CFP: 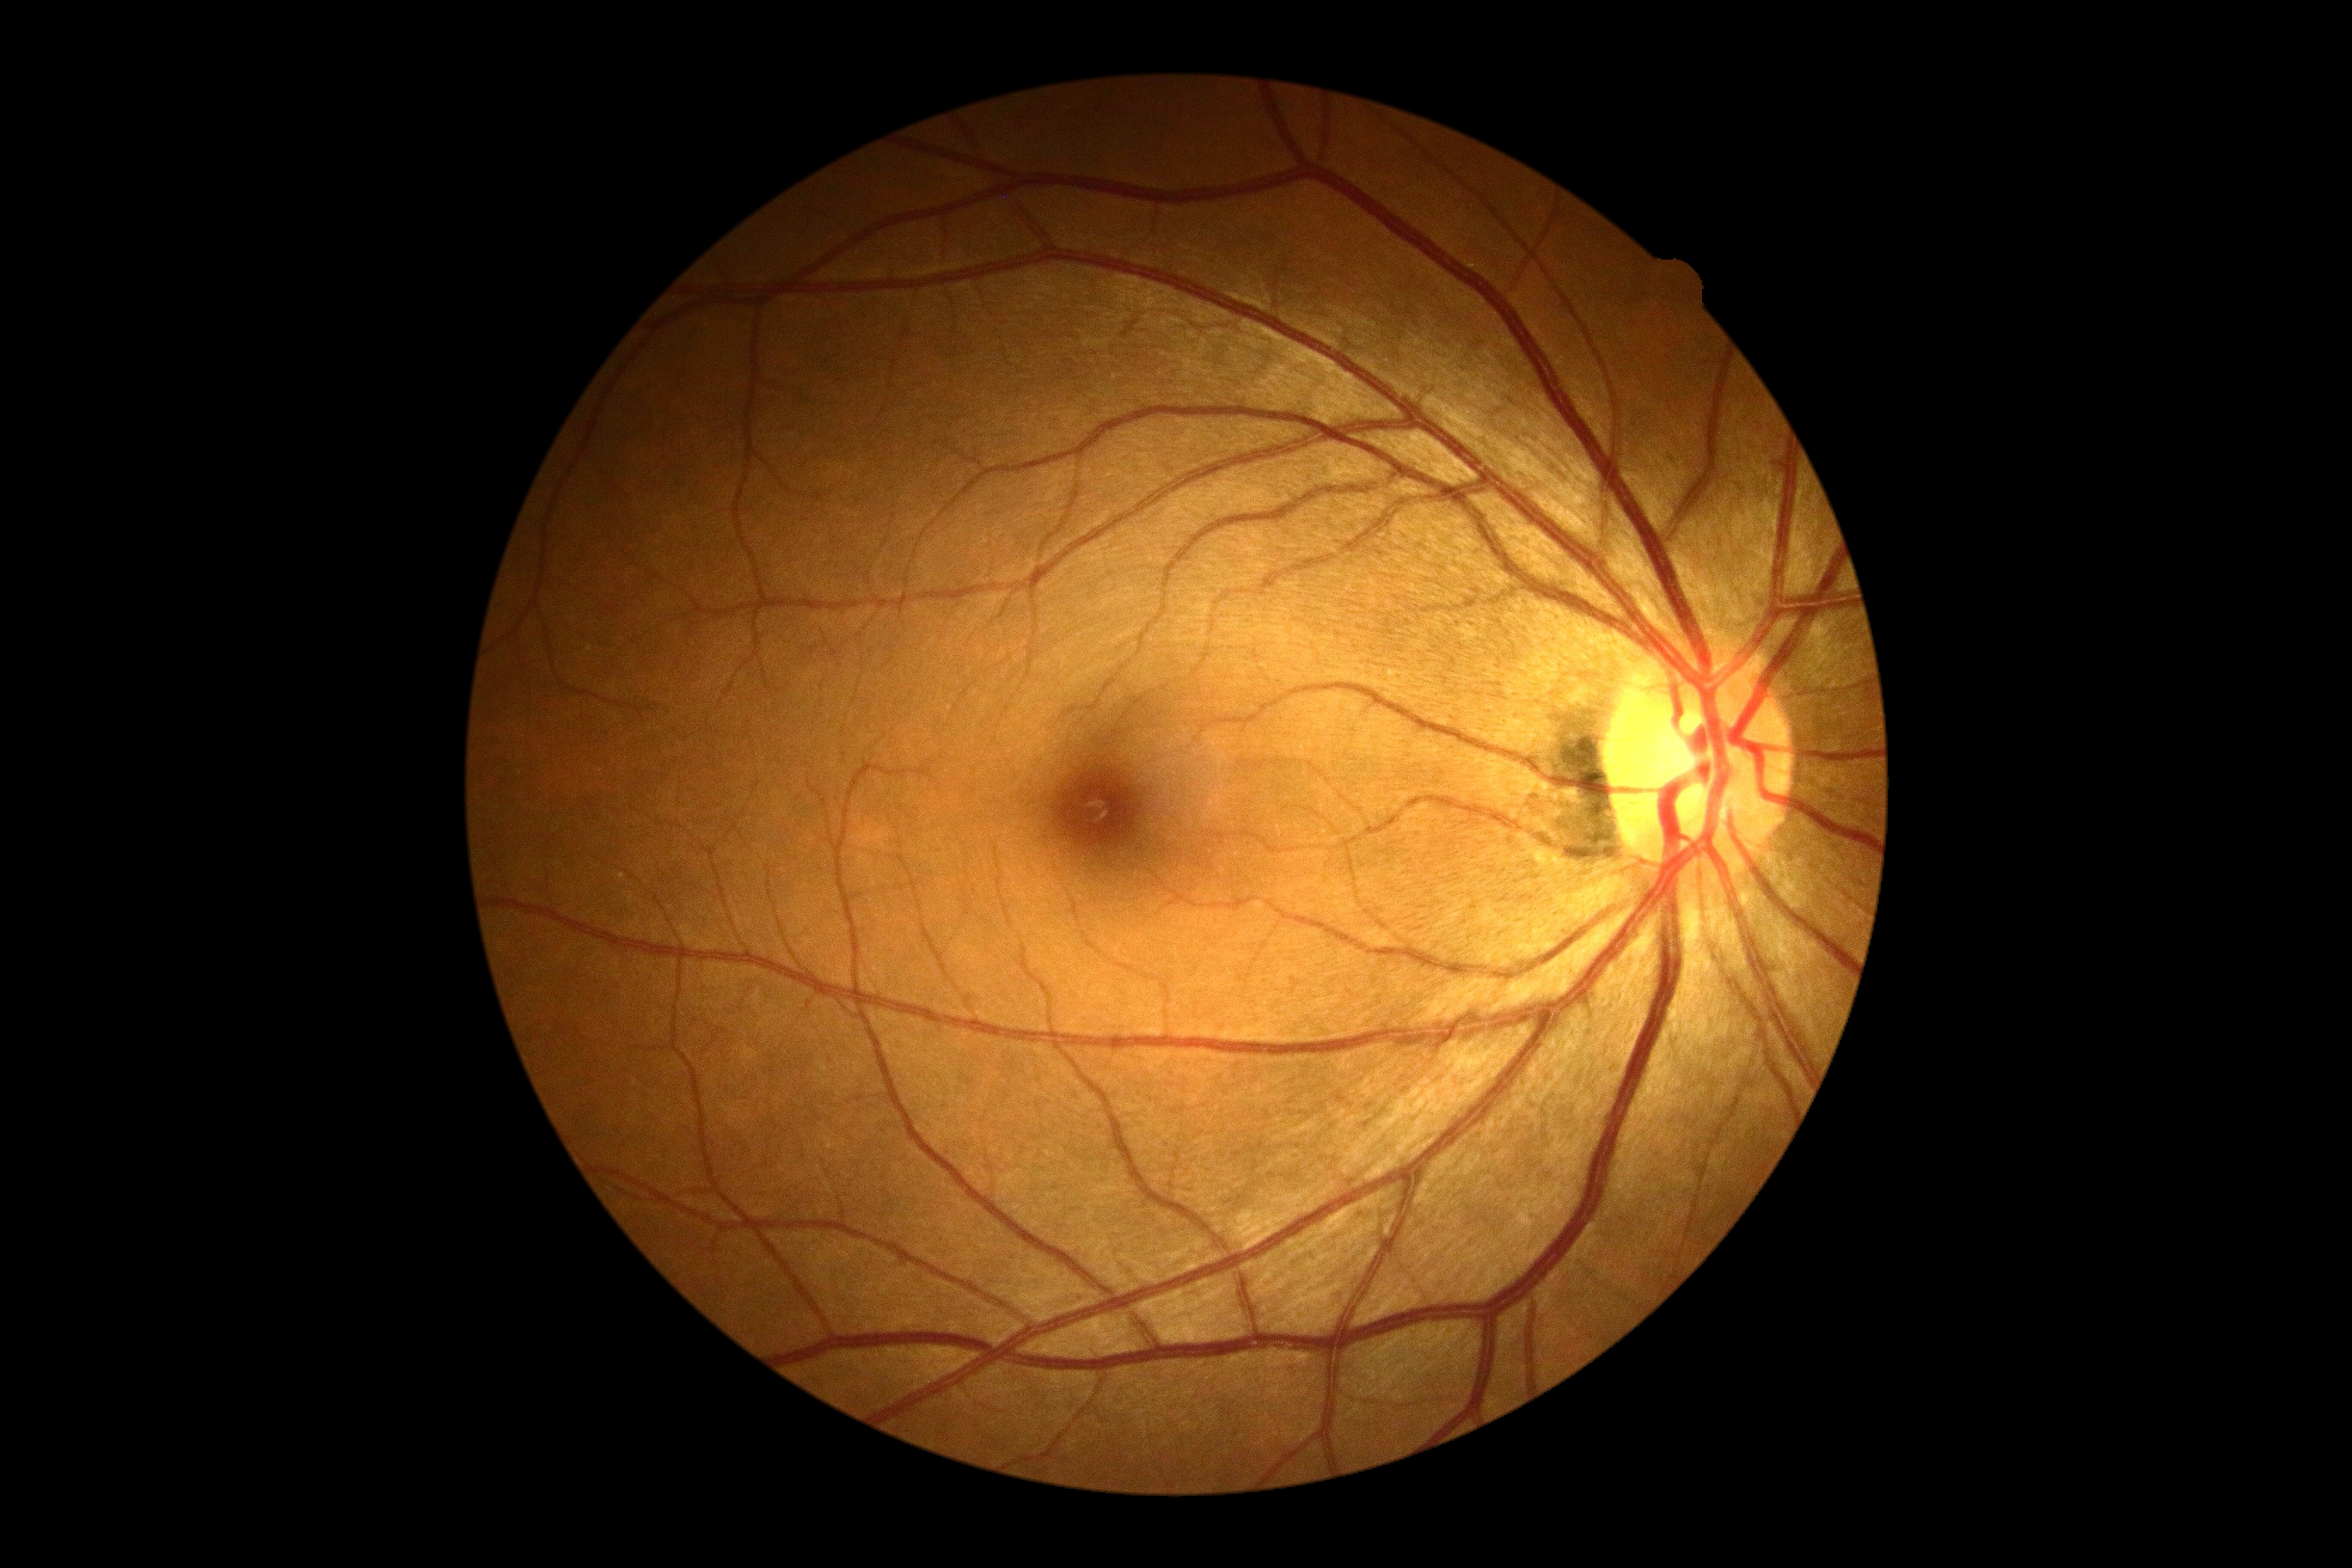

diabetic retinopathy (DR)@0/4.